1240x1240px; infant wide-field fundus photograph; captured with the Phoenix ICON (100° field of view).
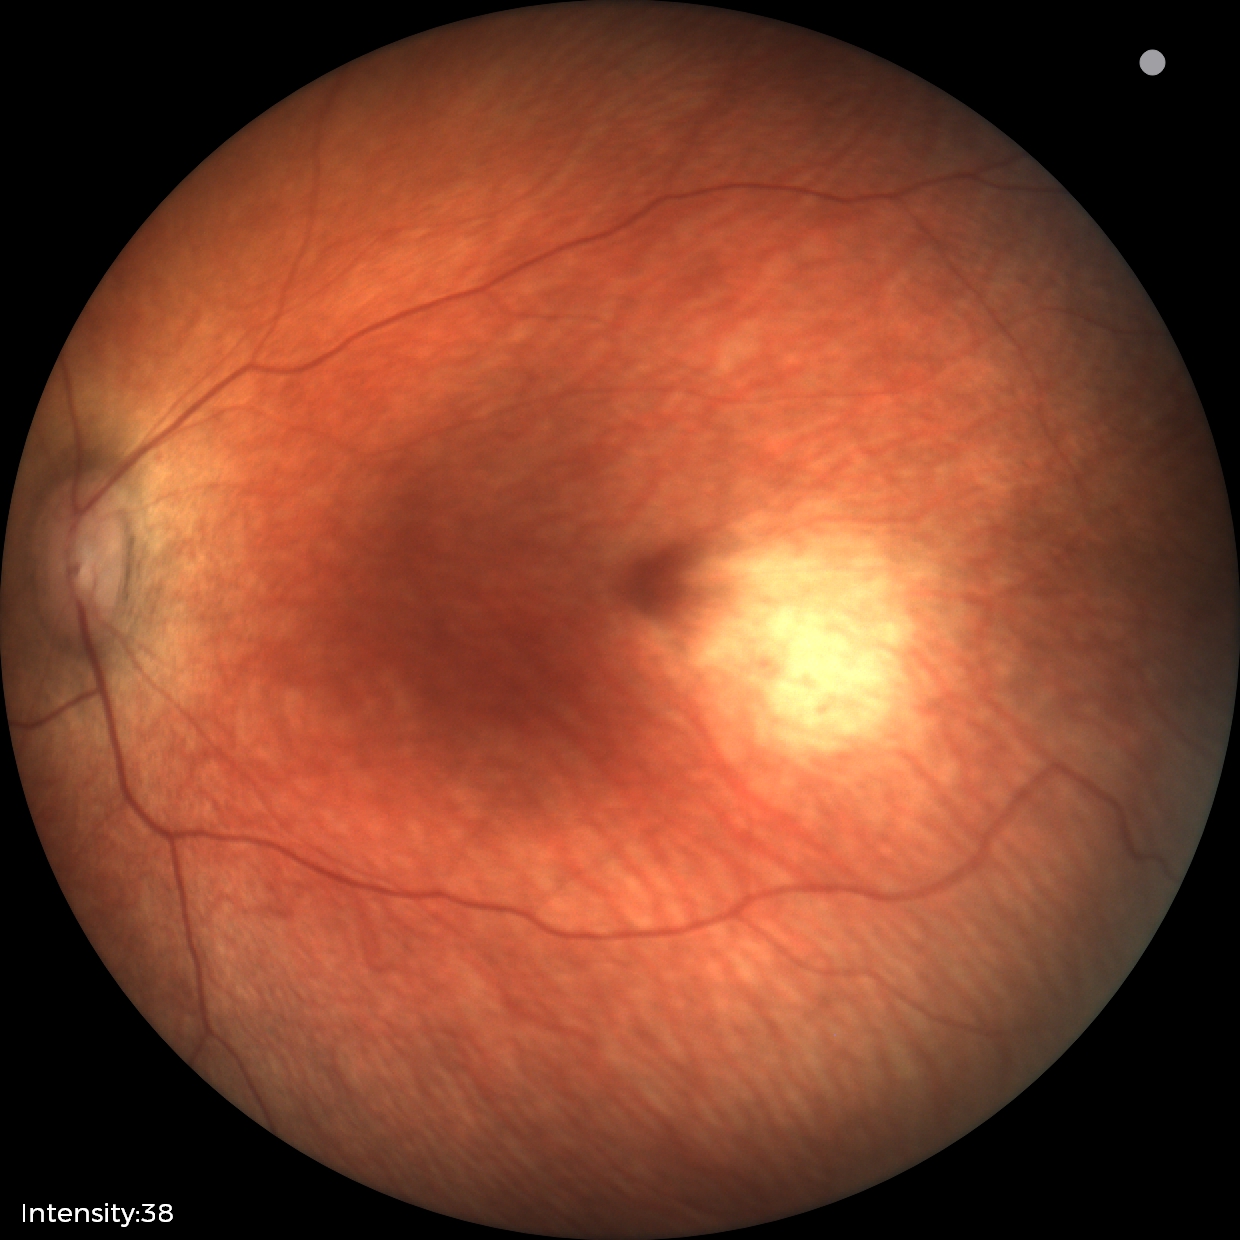 Examination with physiological retinal findings.